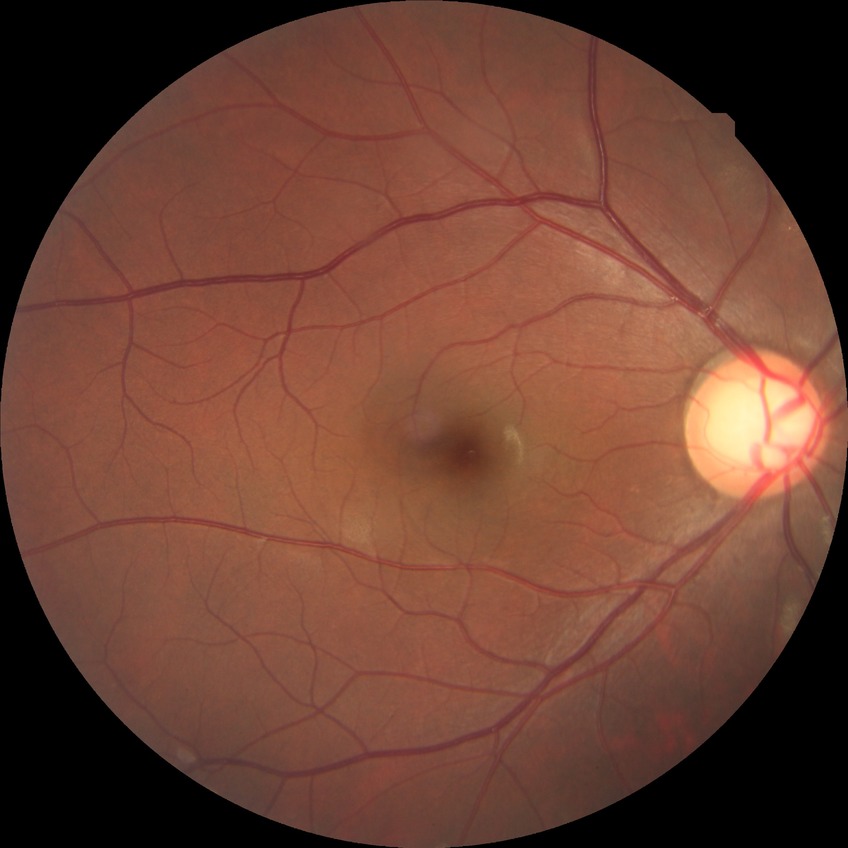

Retinopathy stage: no diabetic retinopathy.